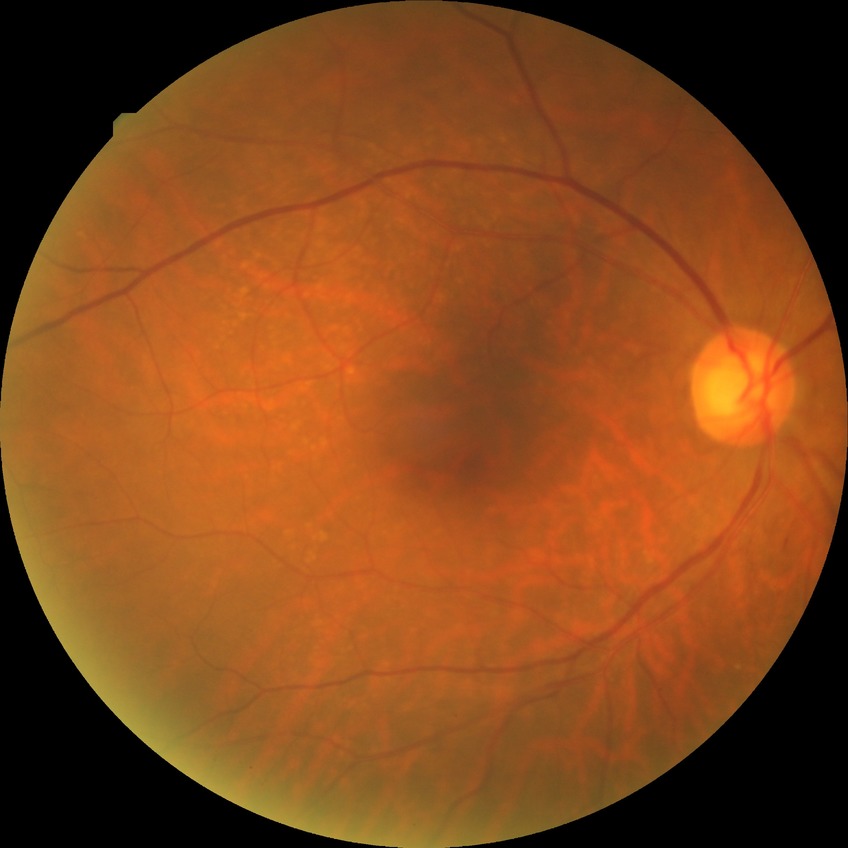

DR class: non-proliferative diabetic retinopathy, diabetic retinopathy (DR): simple diabetic retinopathy (SDR).